45° FOV, color fundus image — 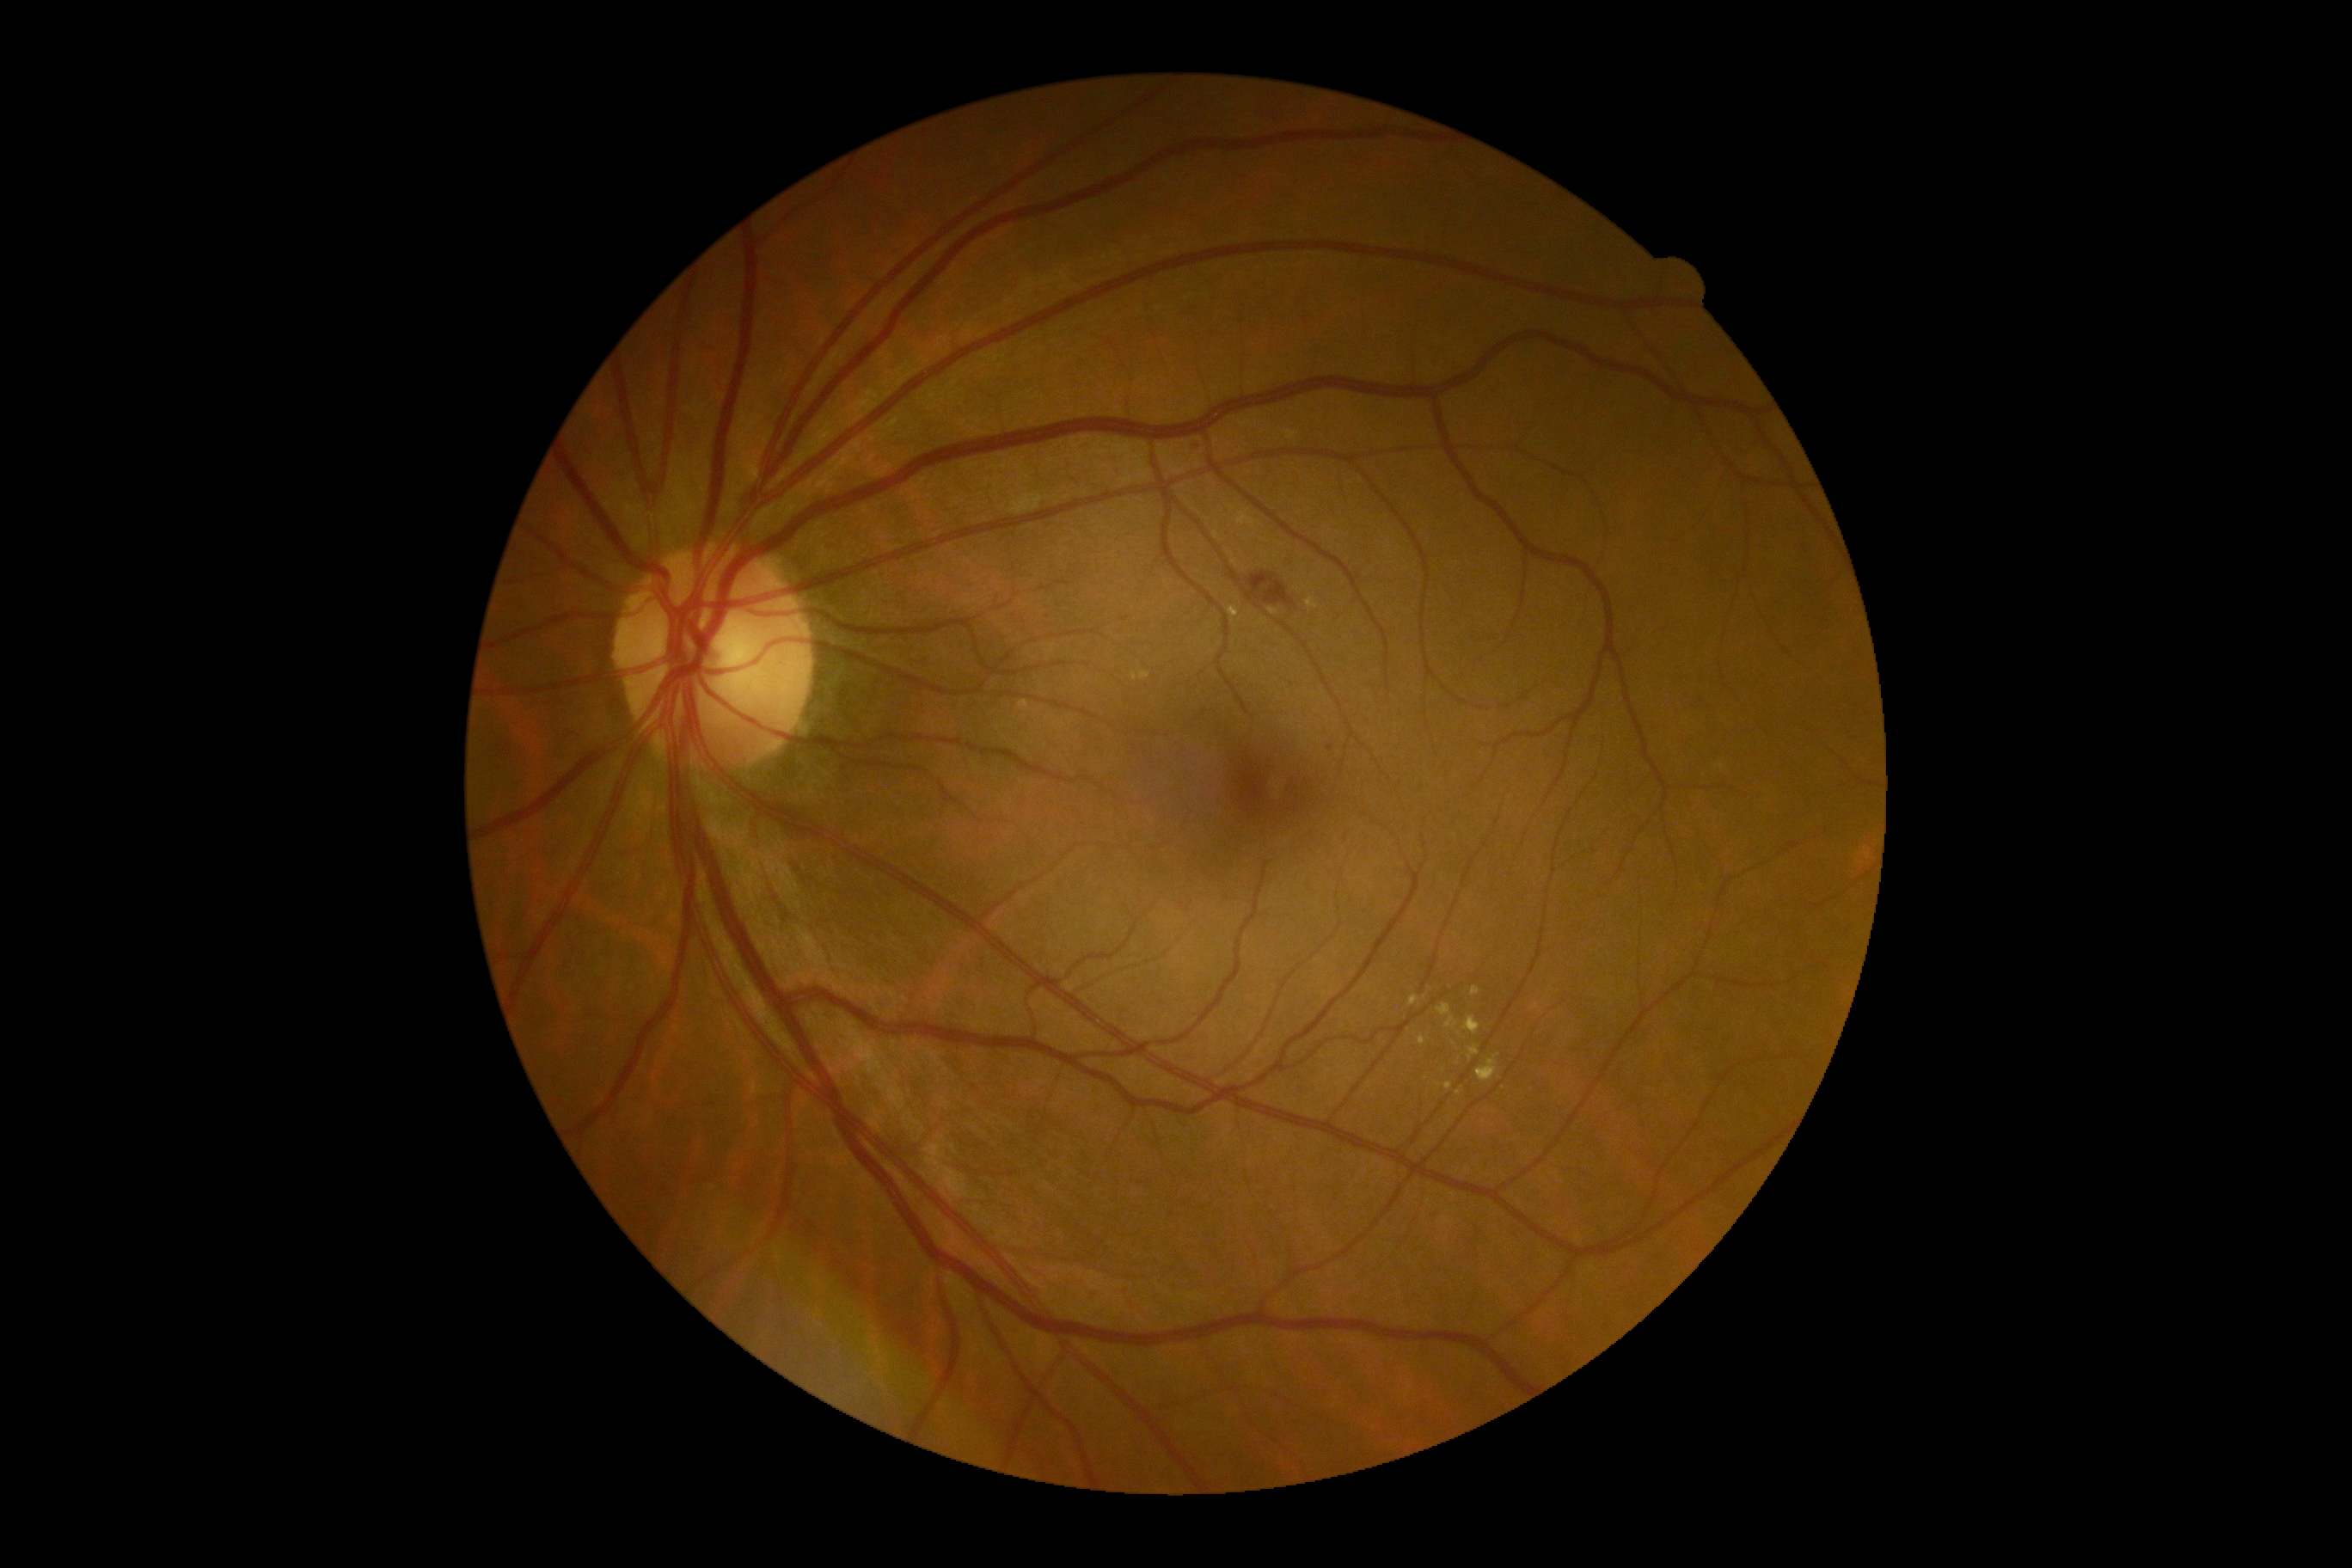
dr_grade: moderate non-proliferative diabetic retinopathy (2)